Infant wide-field fundus photograph · captured with the Phoenix ICON (100° field of view): 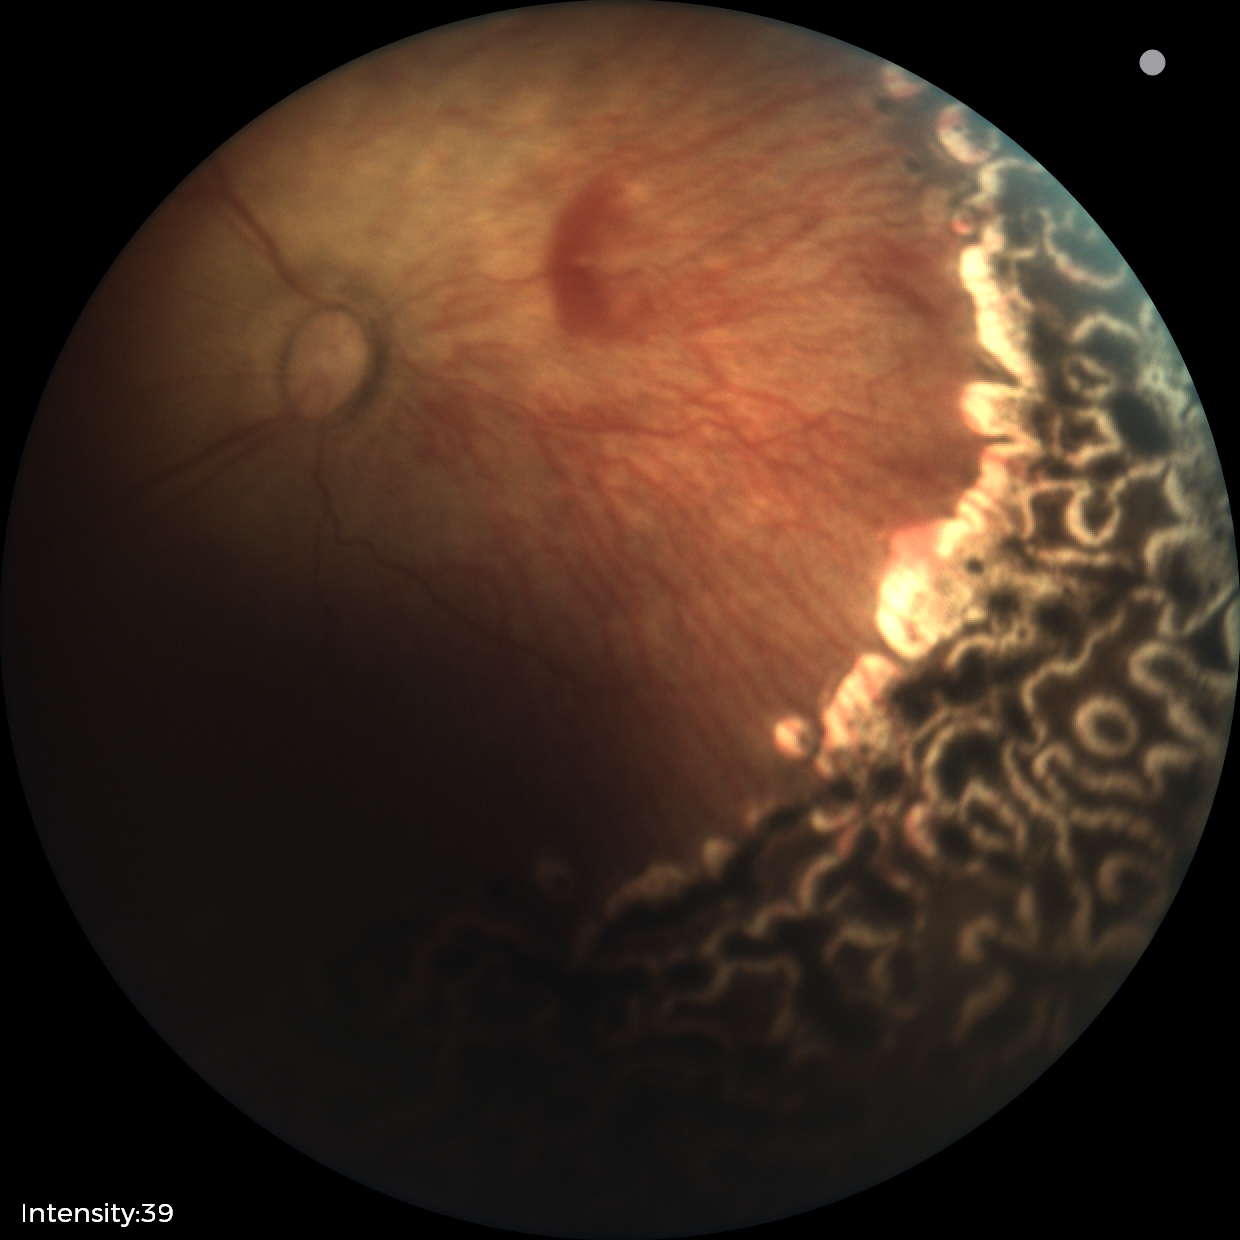
Plus disease: absent
screening diagnosis: status post retinopathy of prematurity